2352 x 1568 pixels
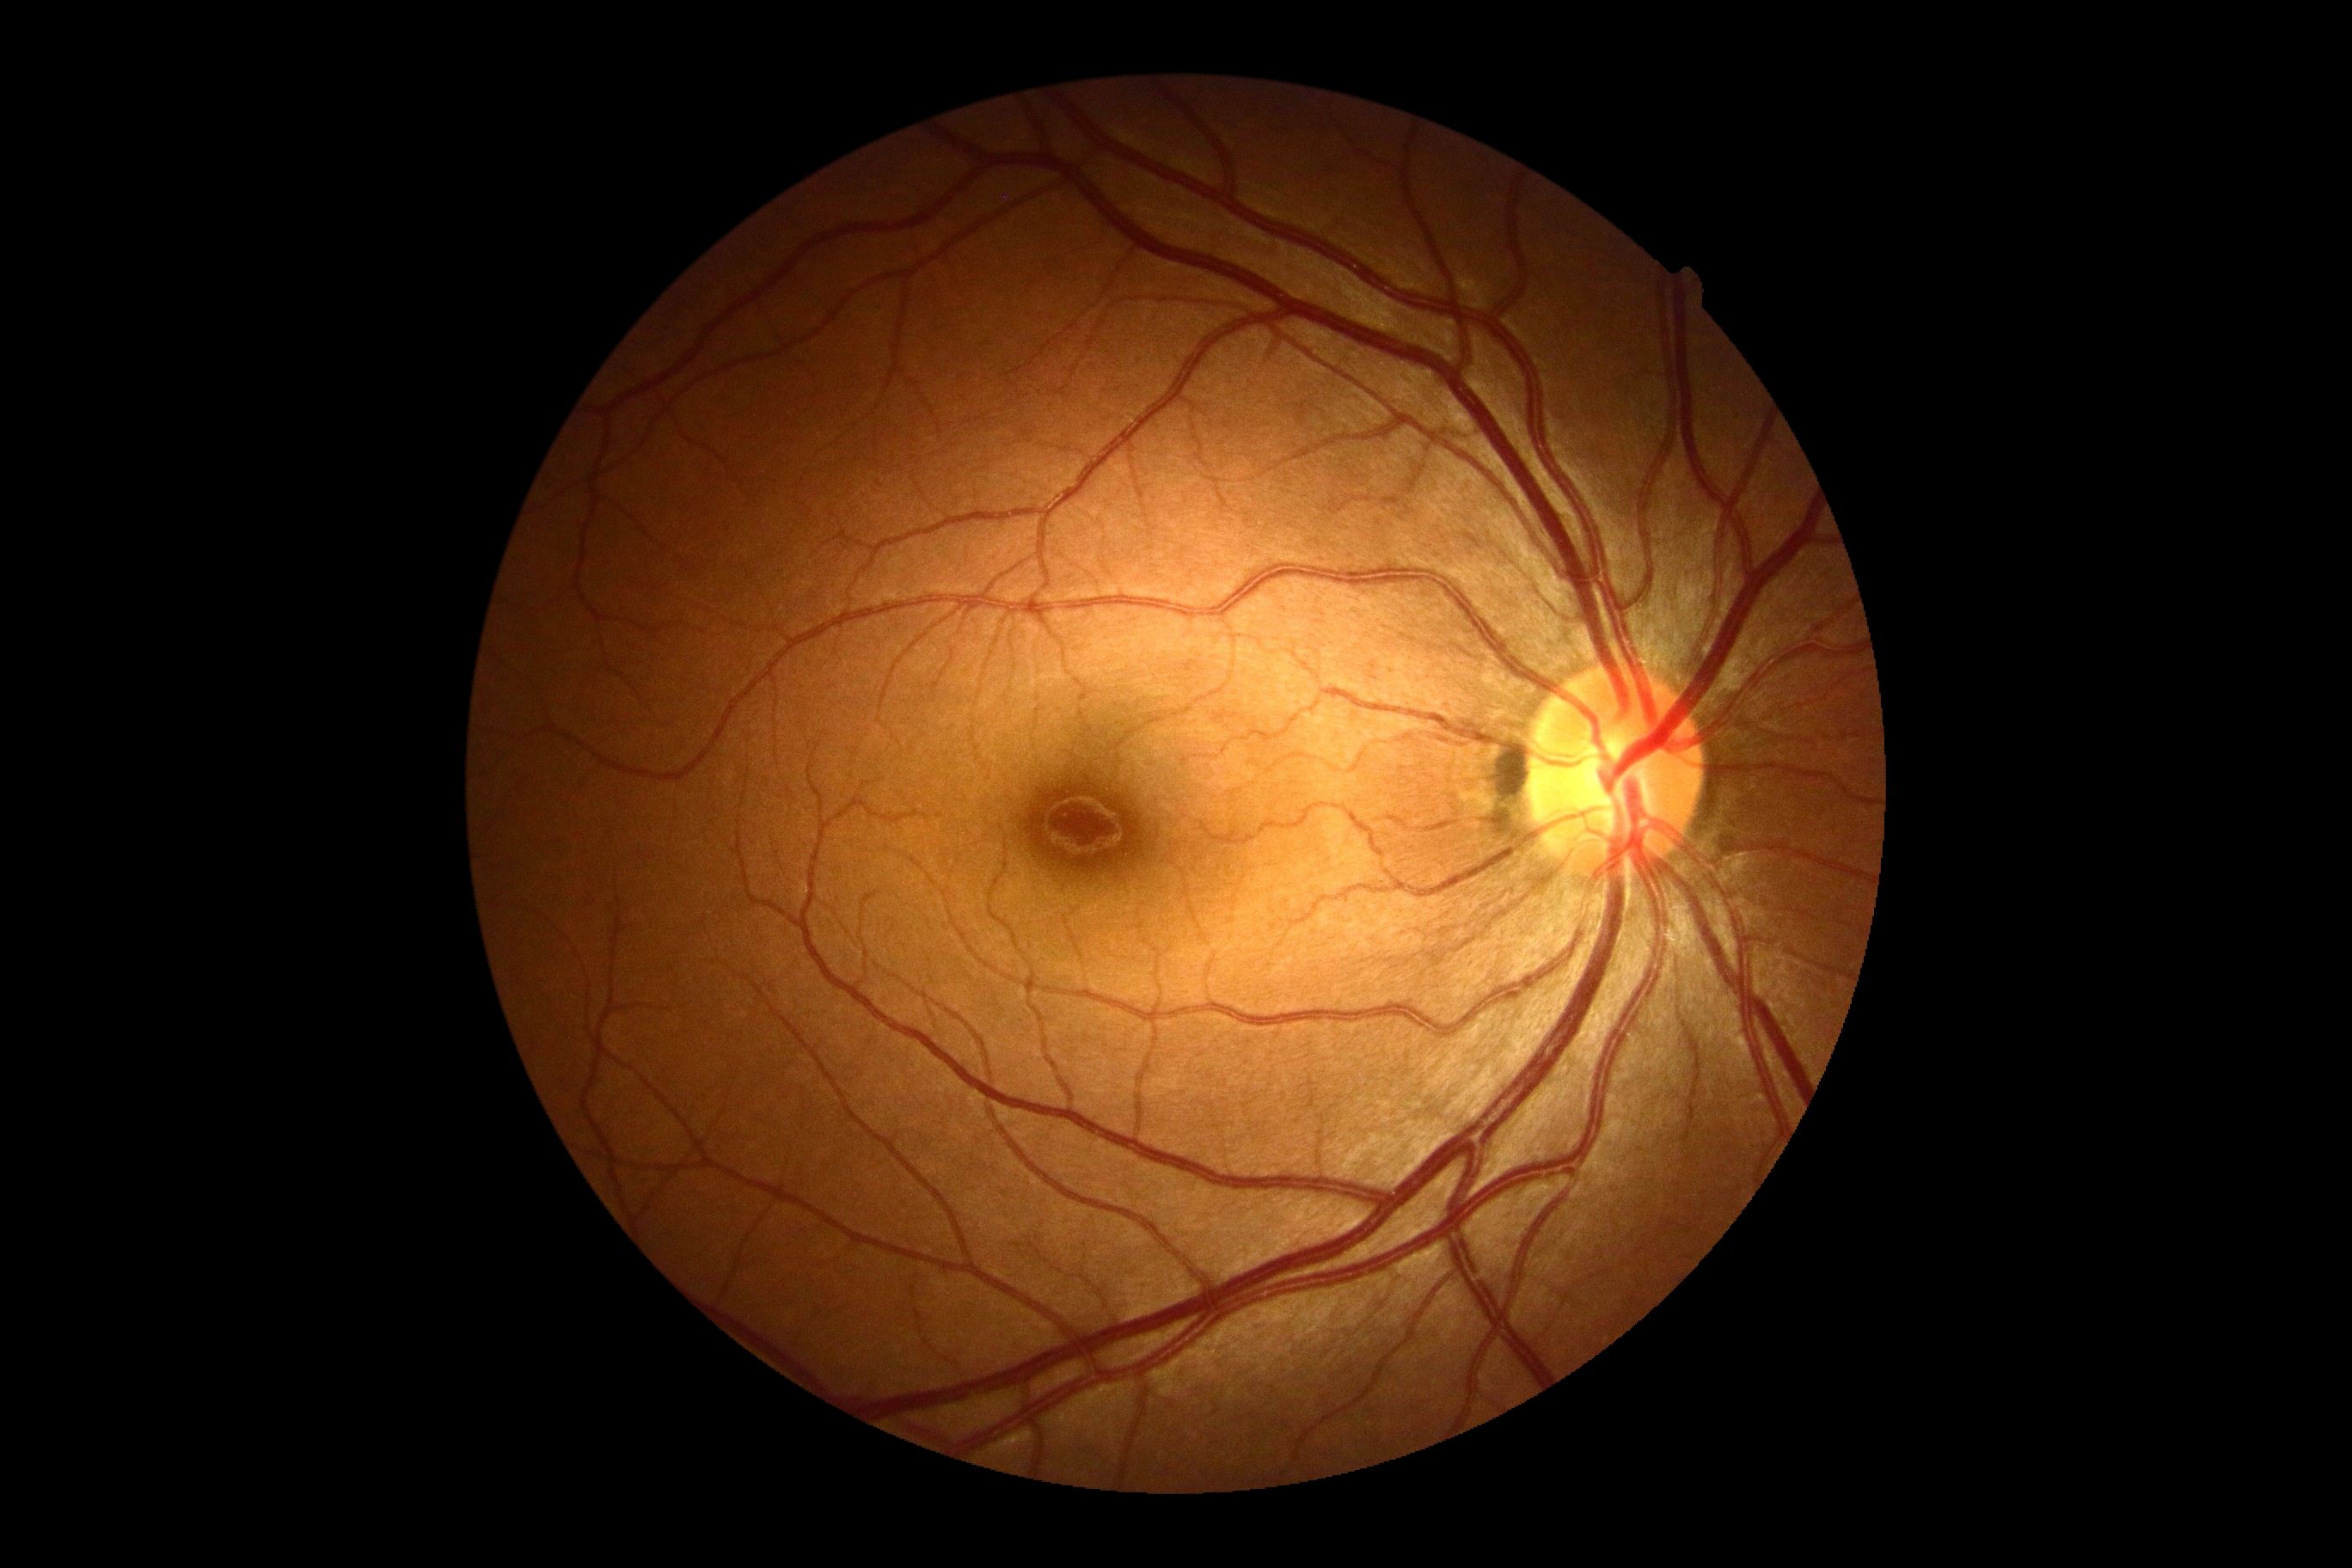

DR impression@no signs of DR, diabetic retinopathy grade@no apparent retinopathy (0).